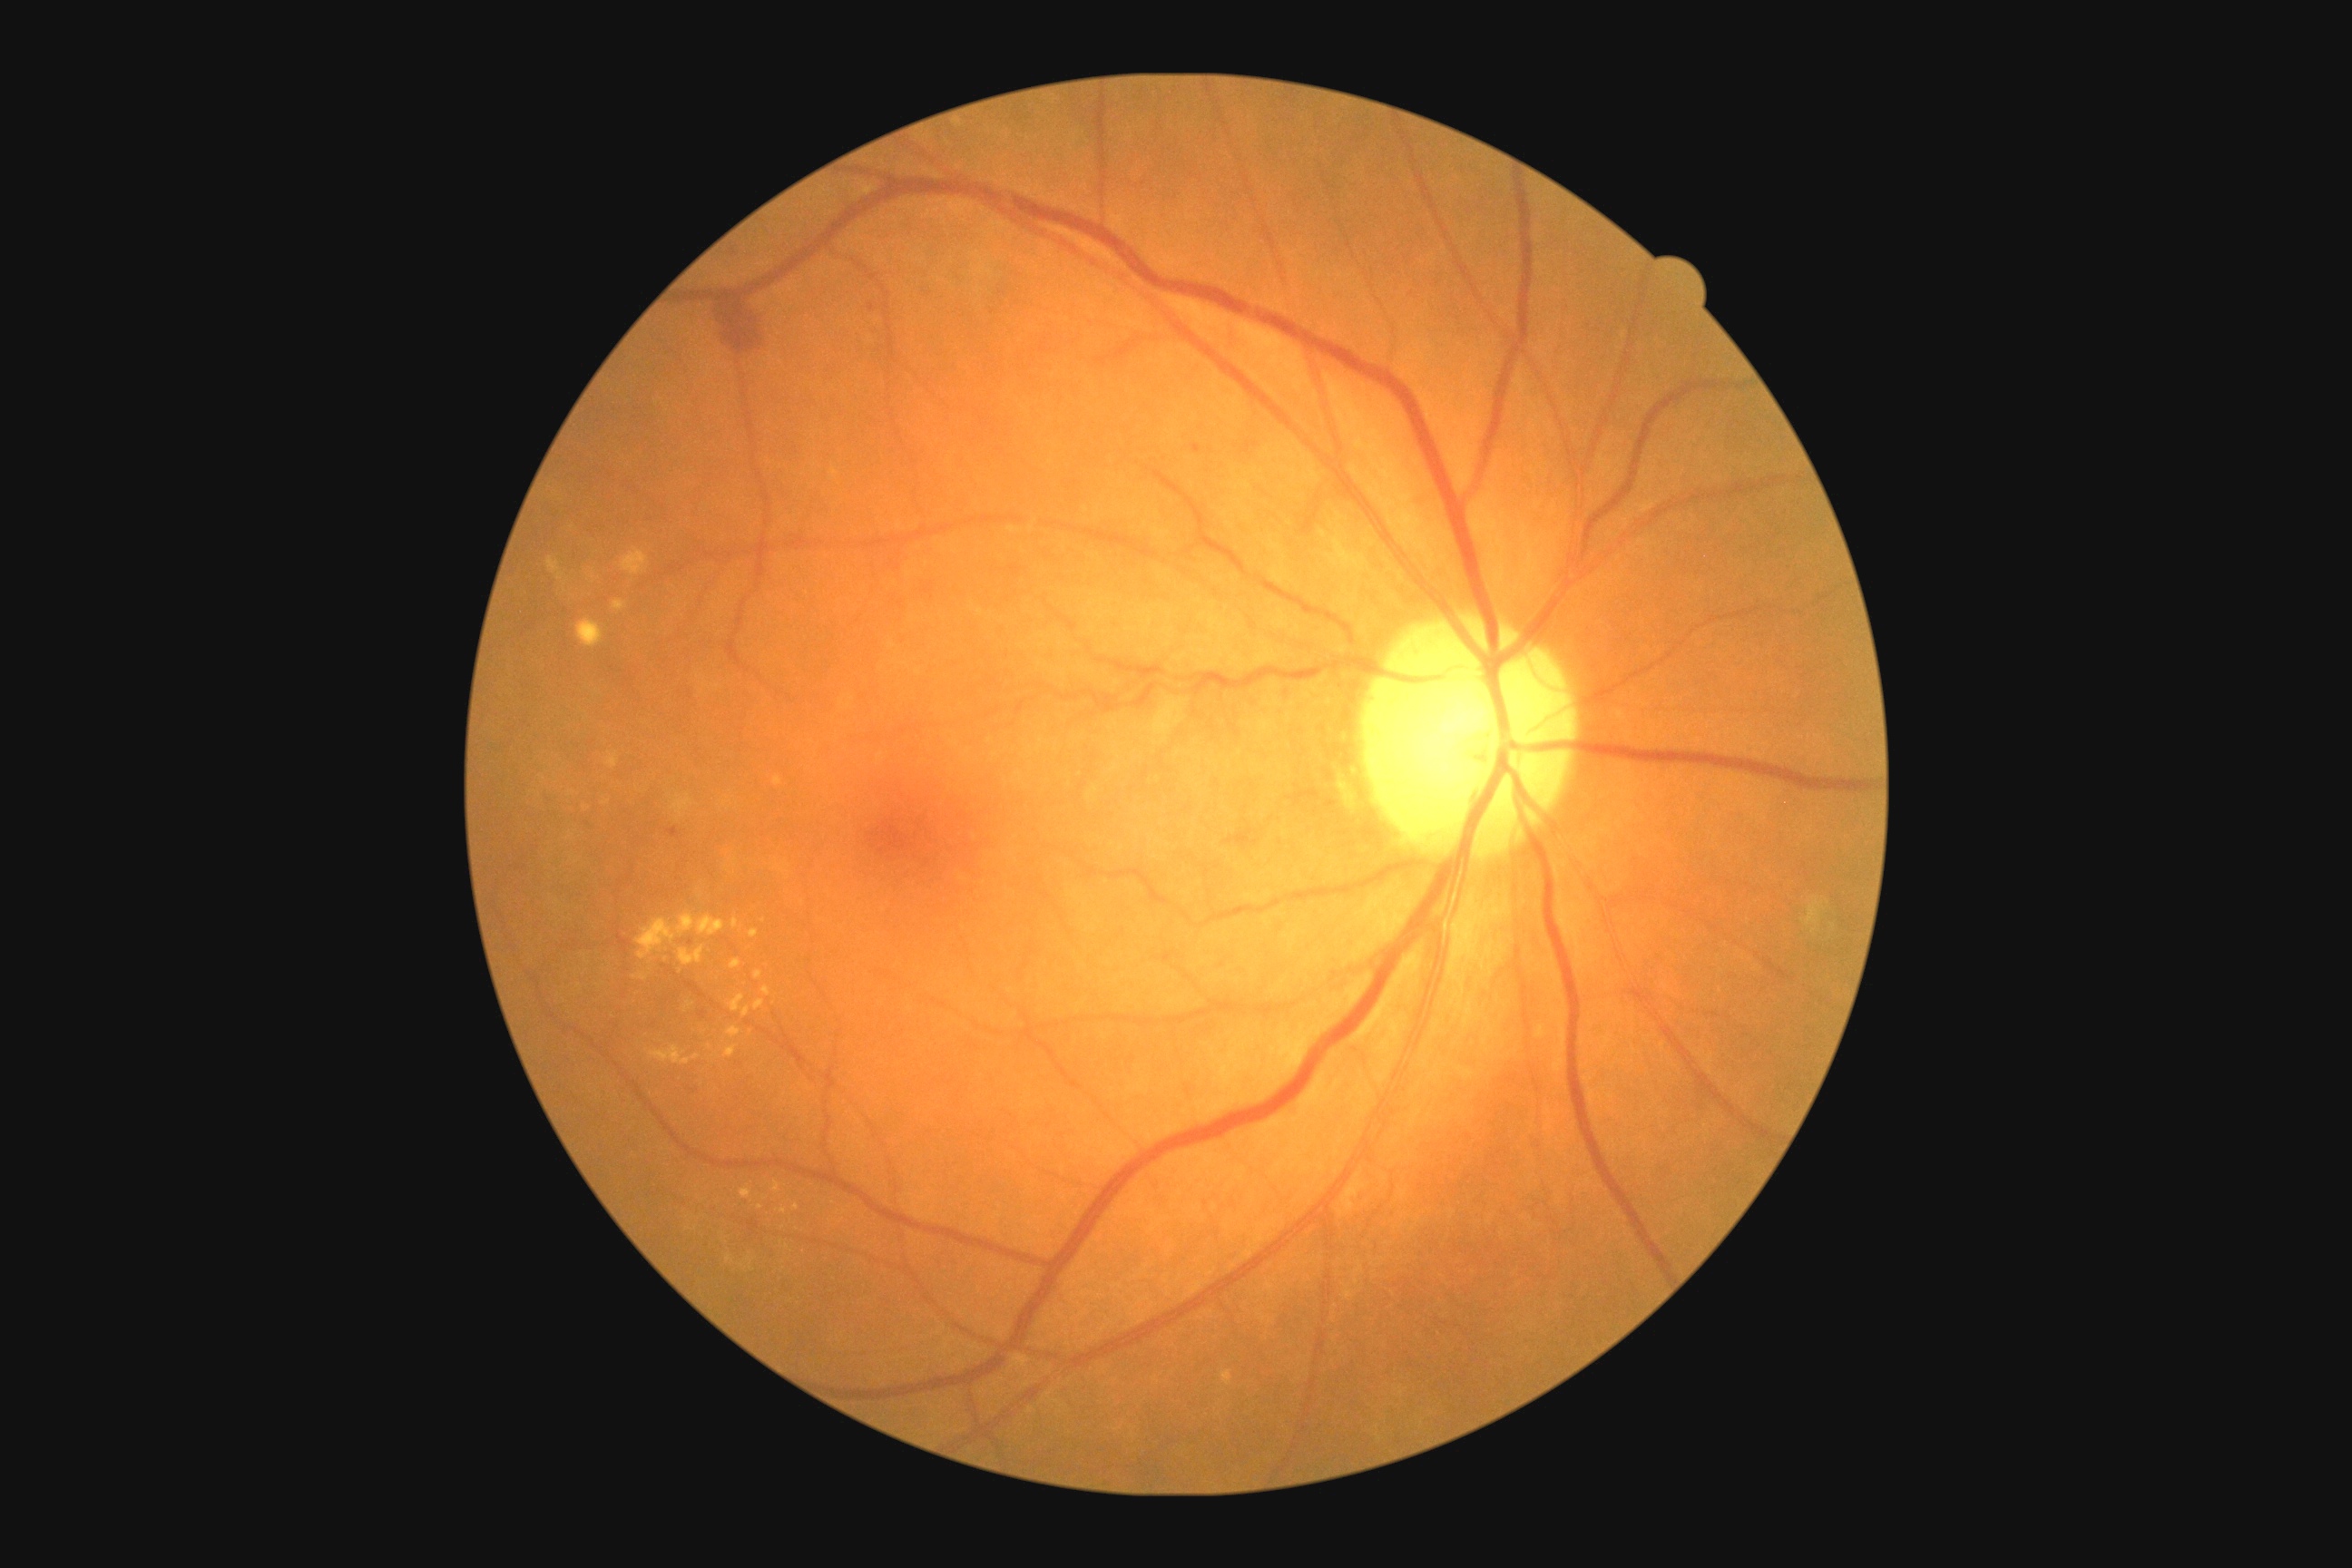 Diabetic retinopathy (DR) is grade 2 — more than just microaneurysms but less than severe NPDR.